2352 x 1568 pixels, retinal fundus photograph, 45° FOV
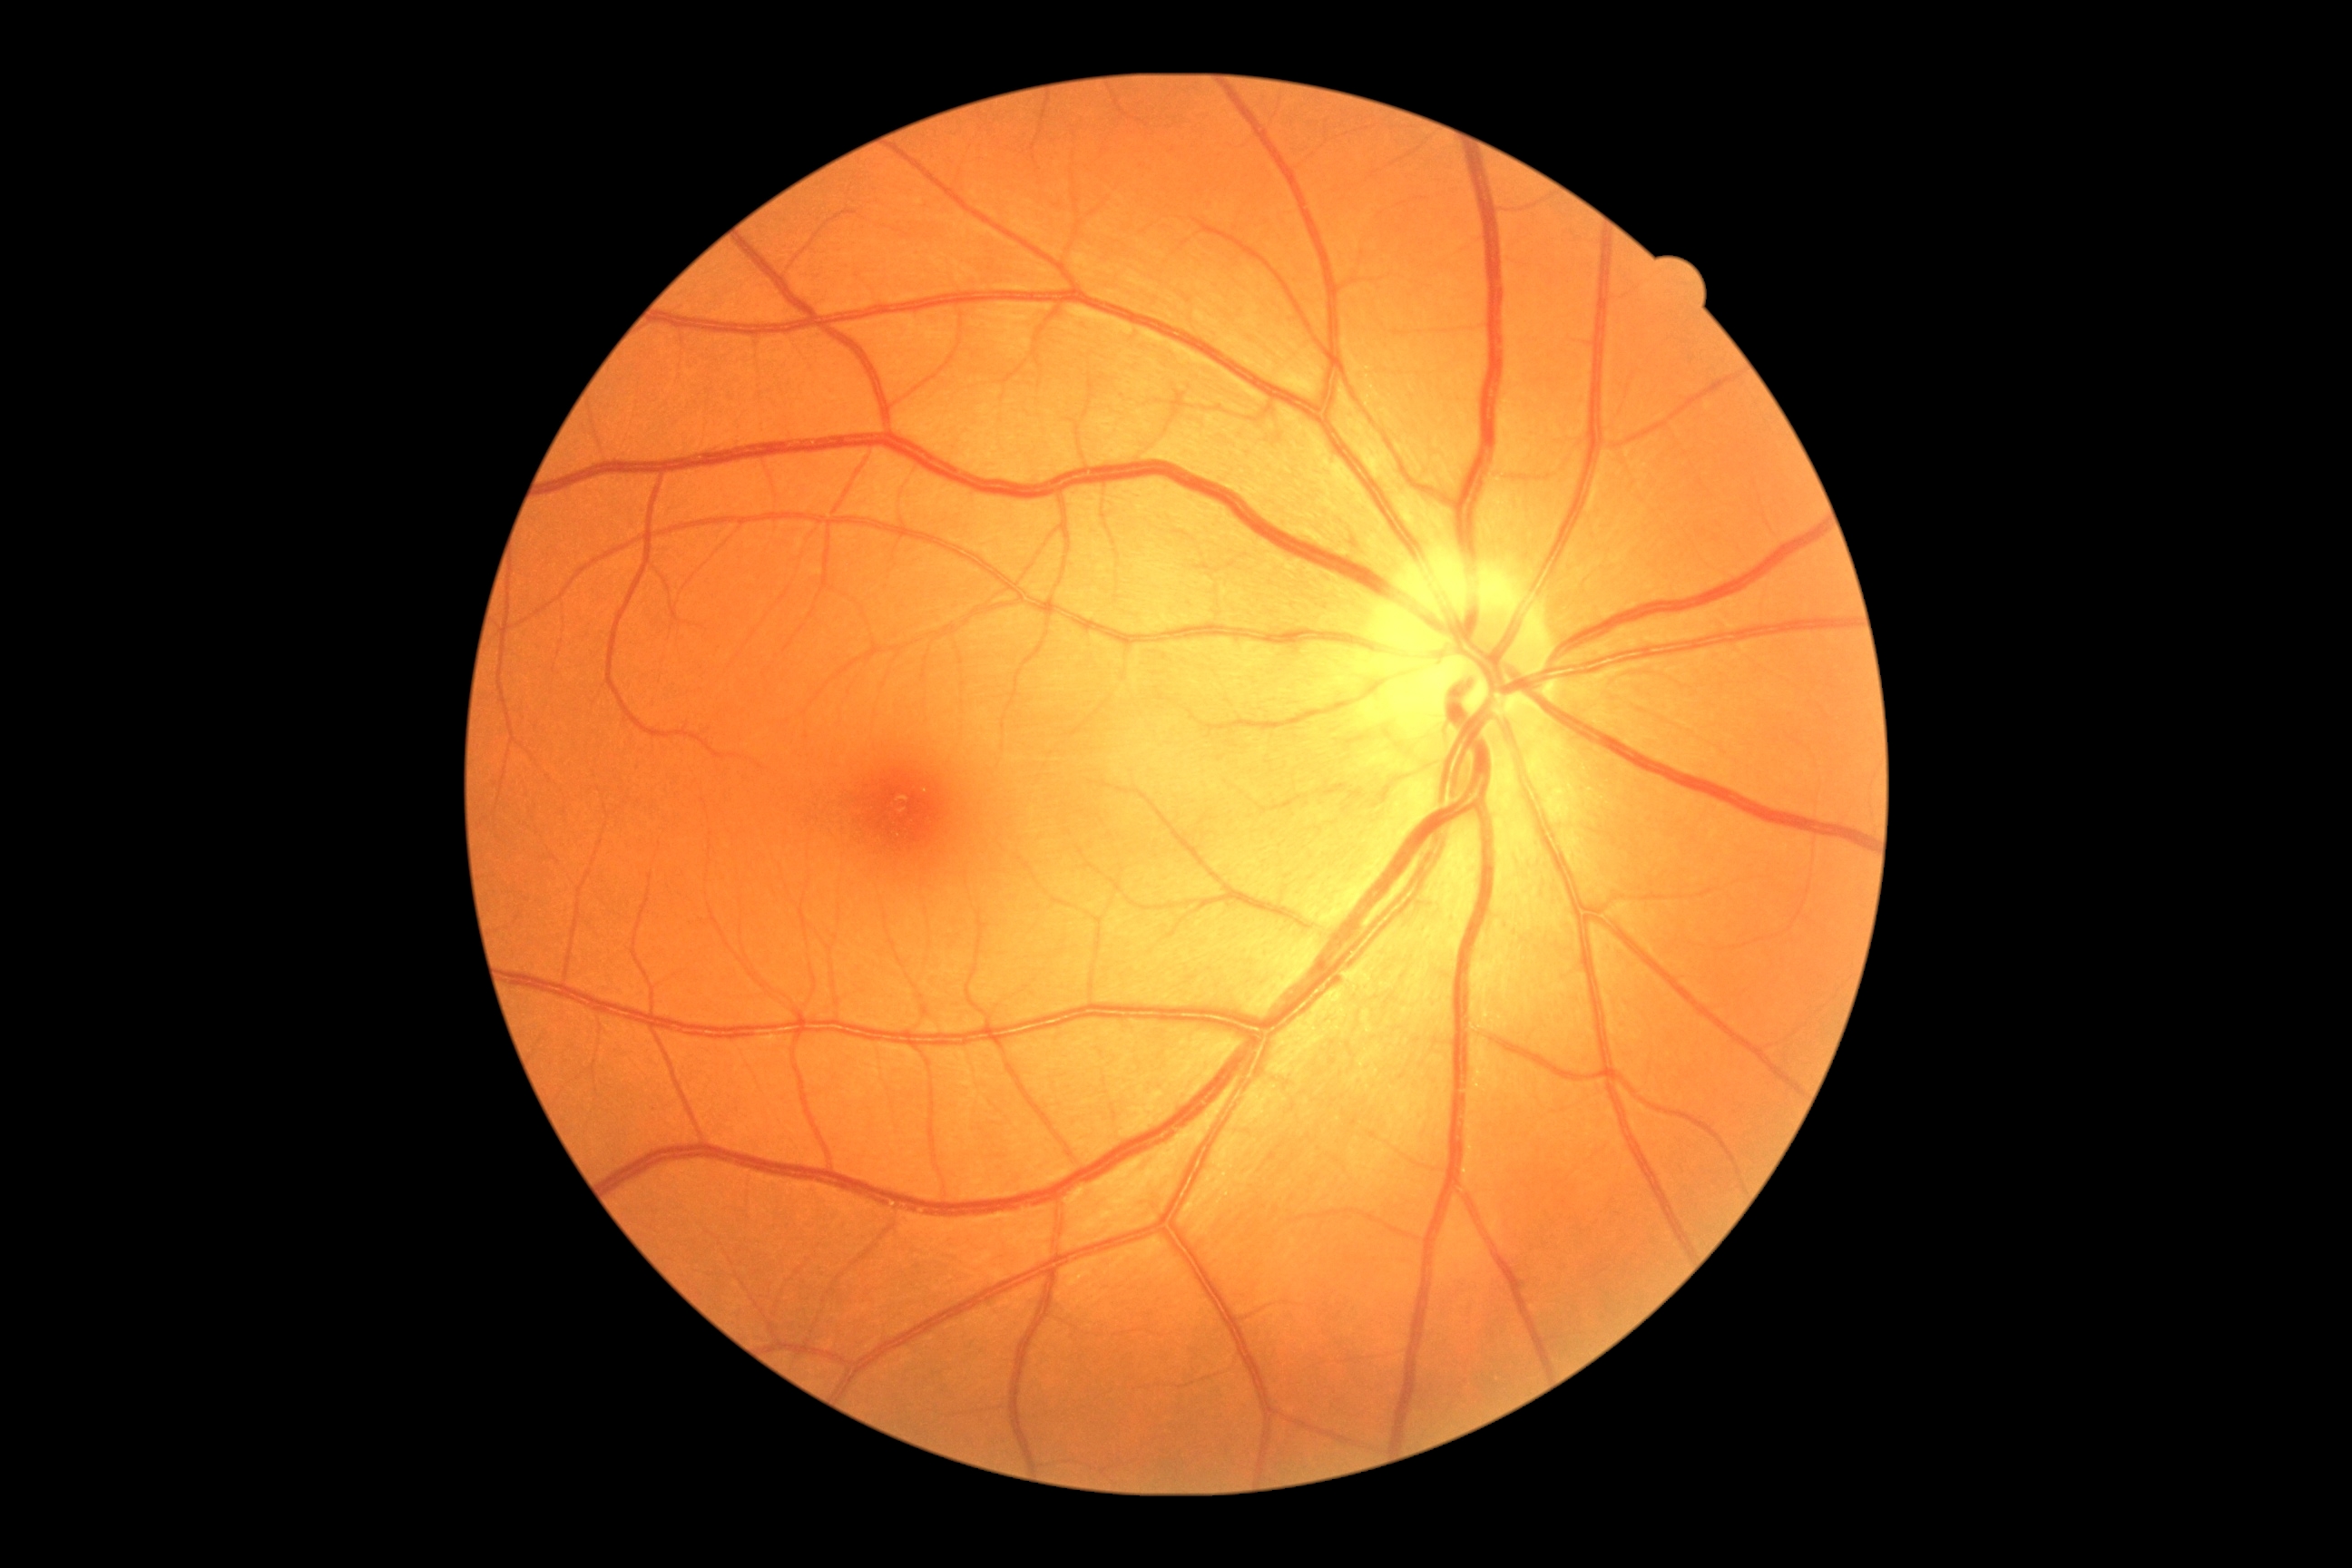

Diabetic retinopathy: grade 0 (no apparent retinopathy).
No signs of diabetic retinopathy.